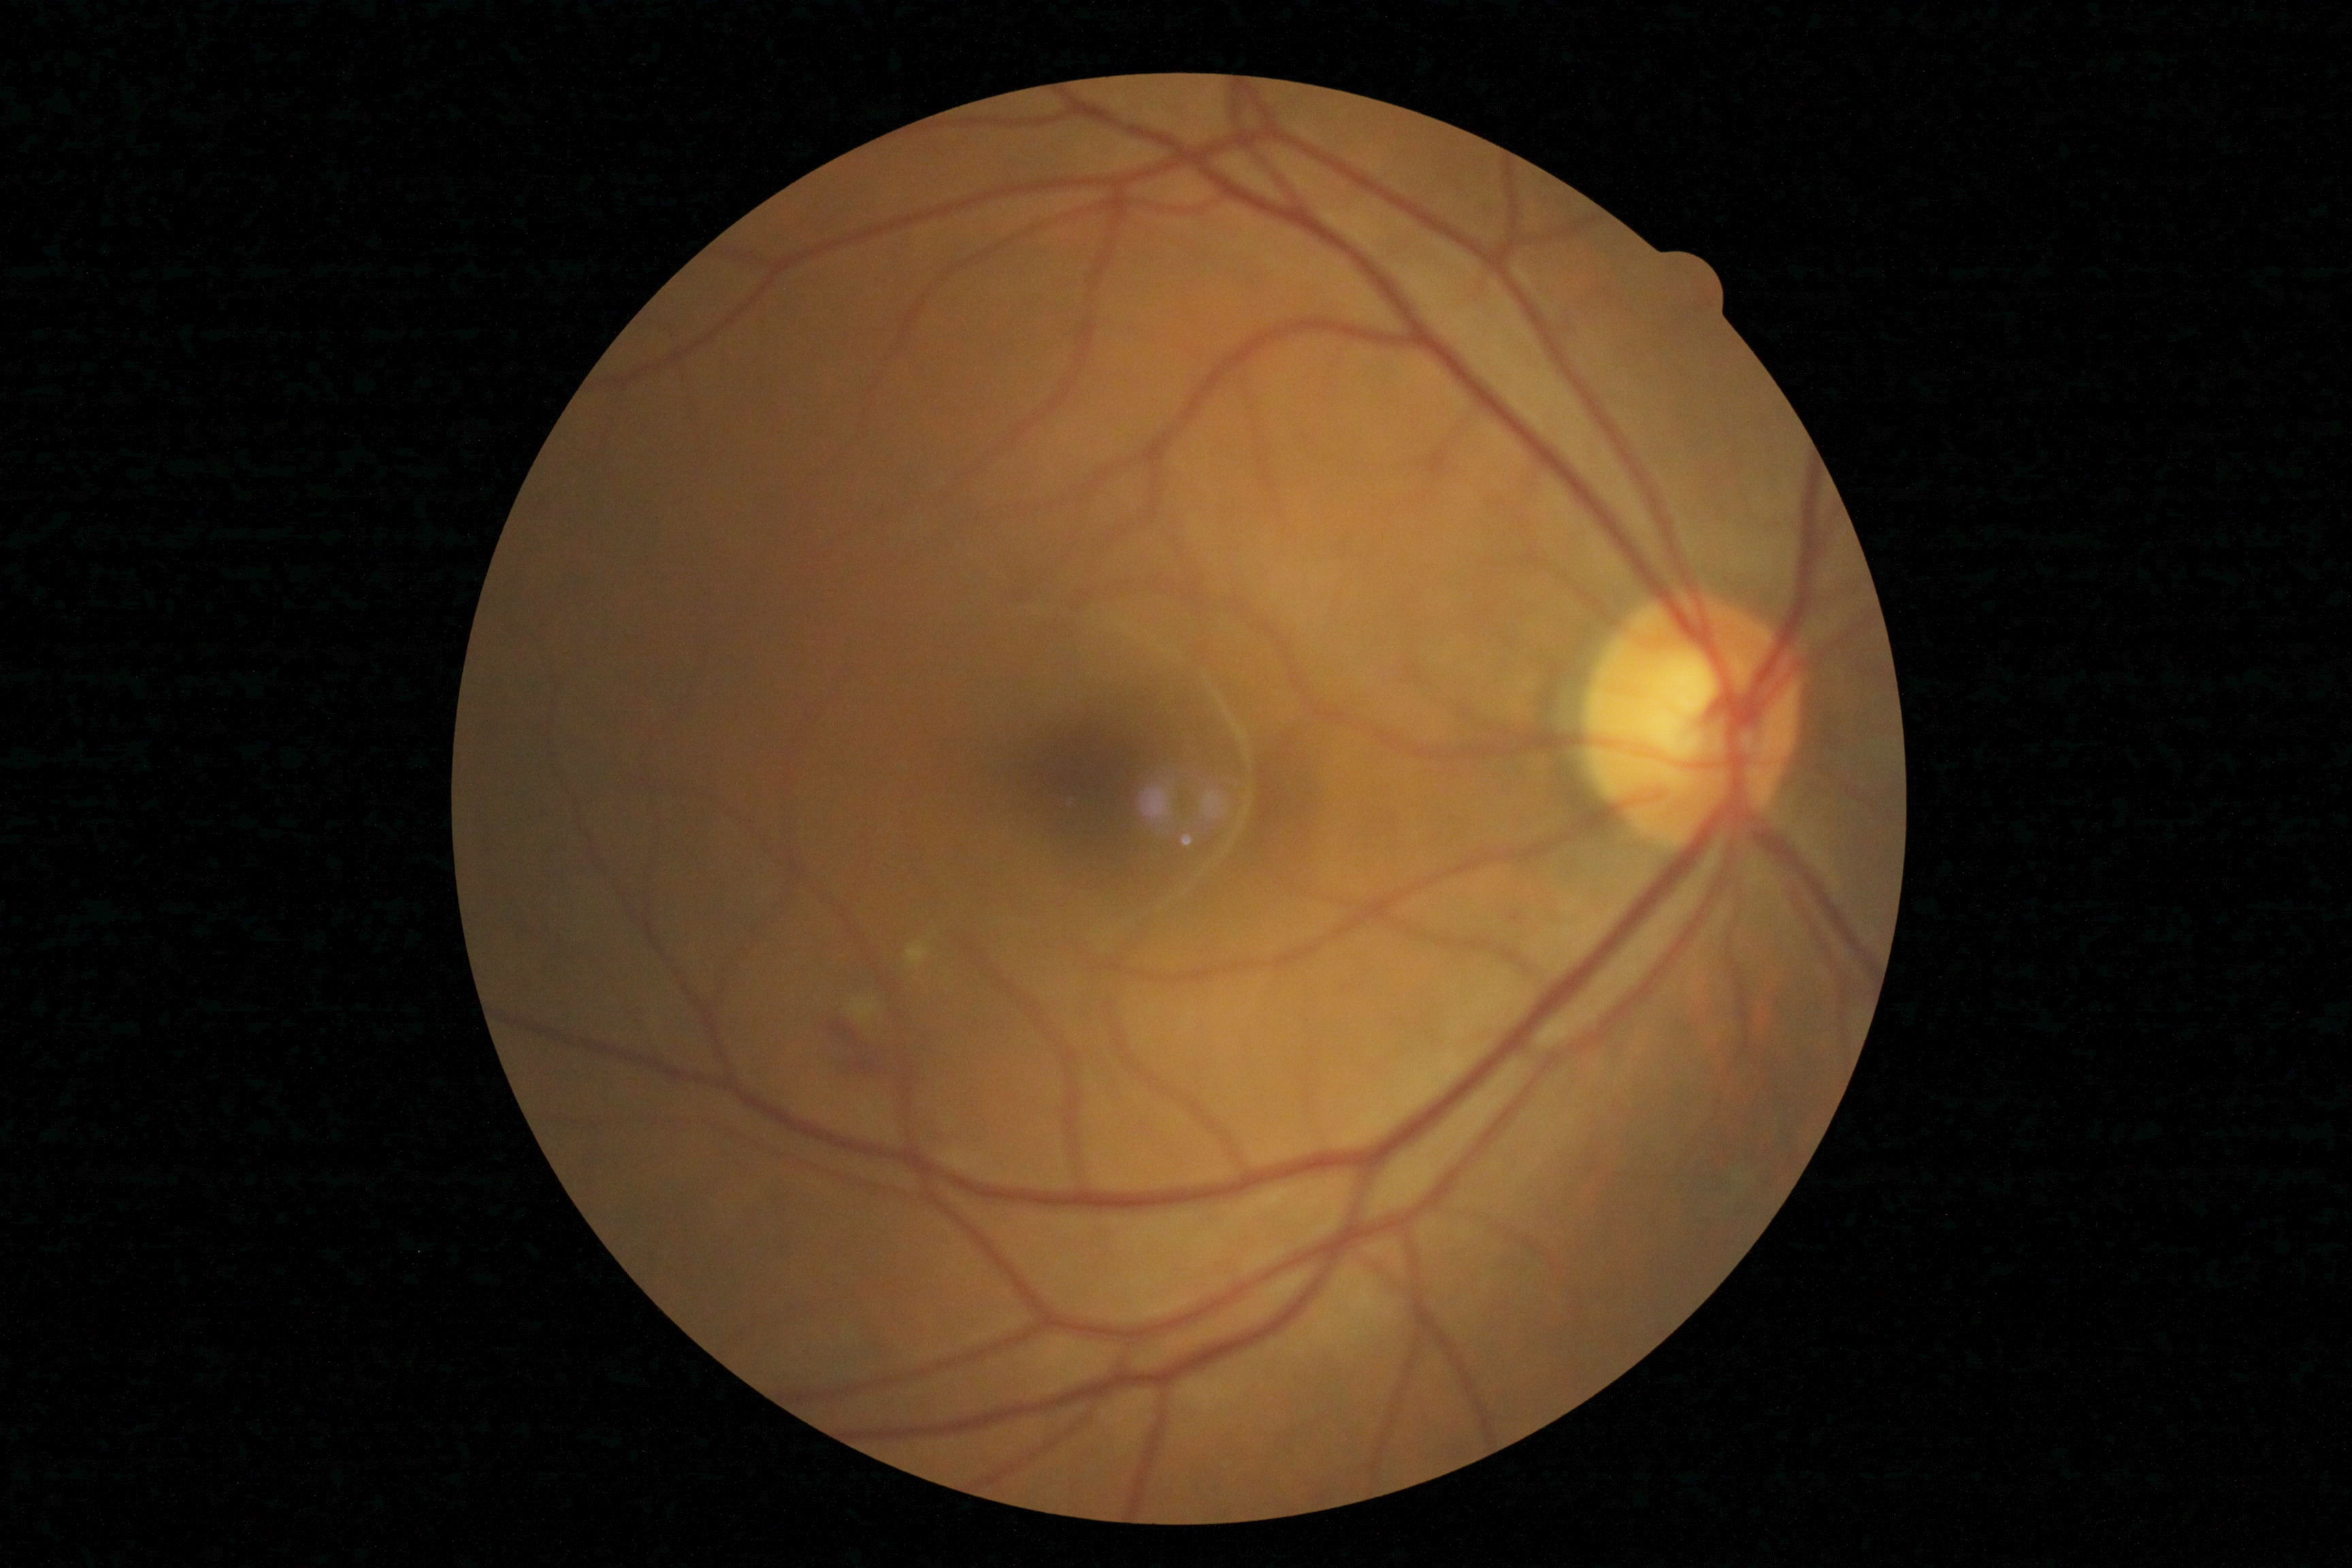 – diabetic retinopathy severity — moderate non-proliferative diabetic retinopathy (grade 2)